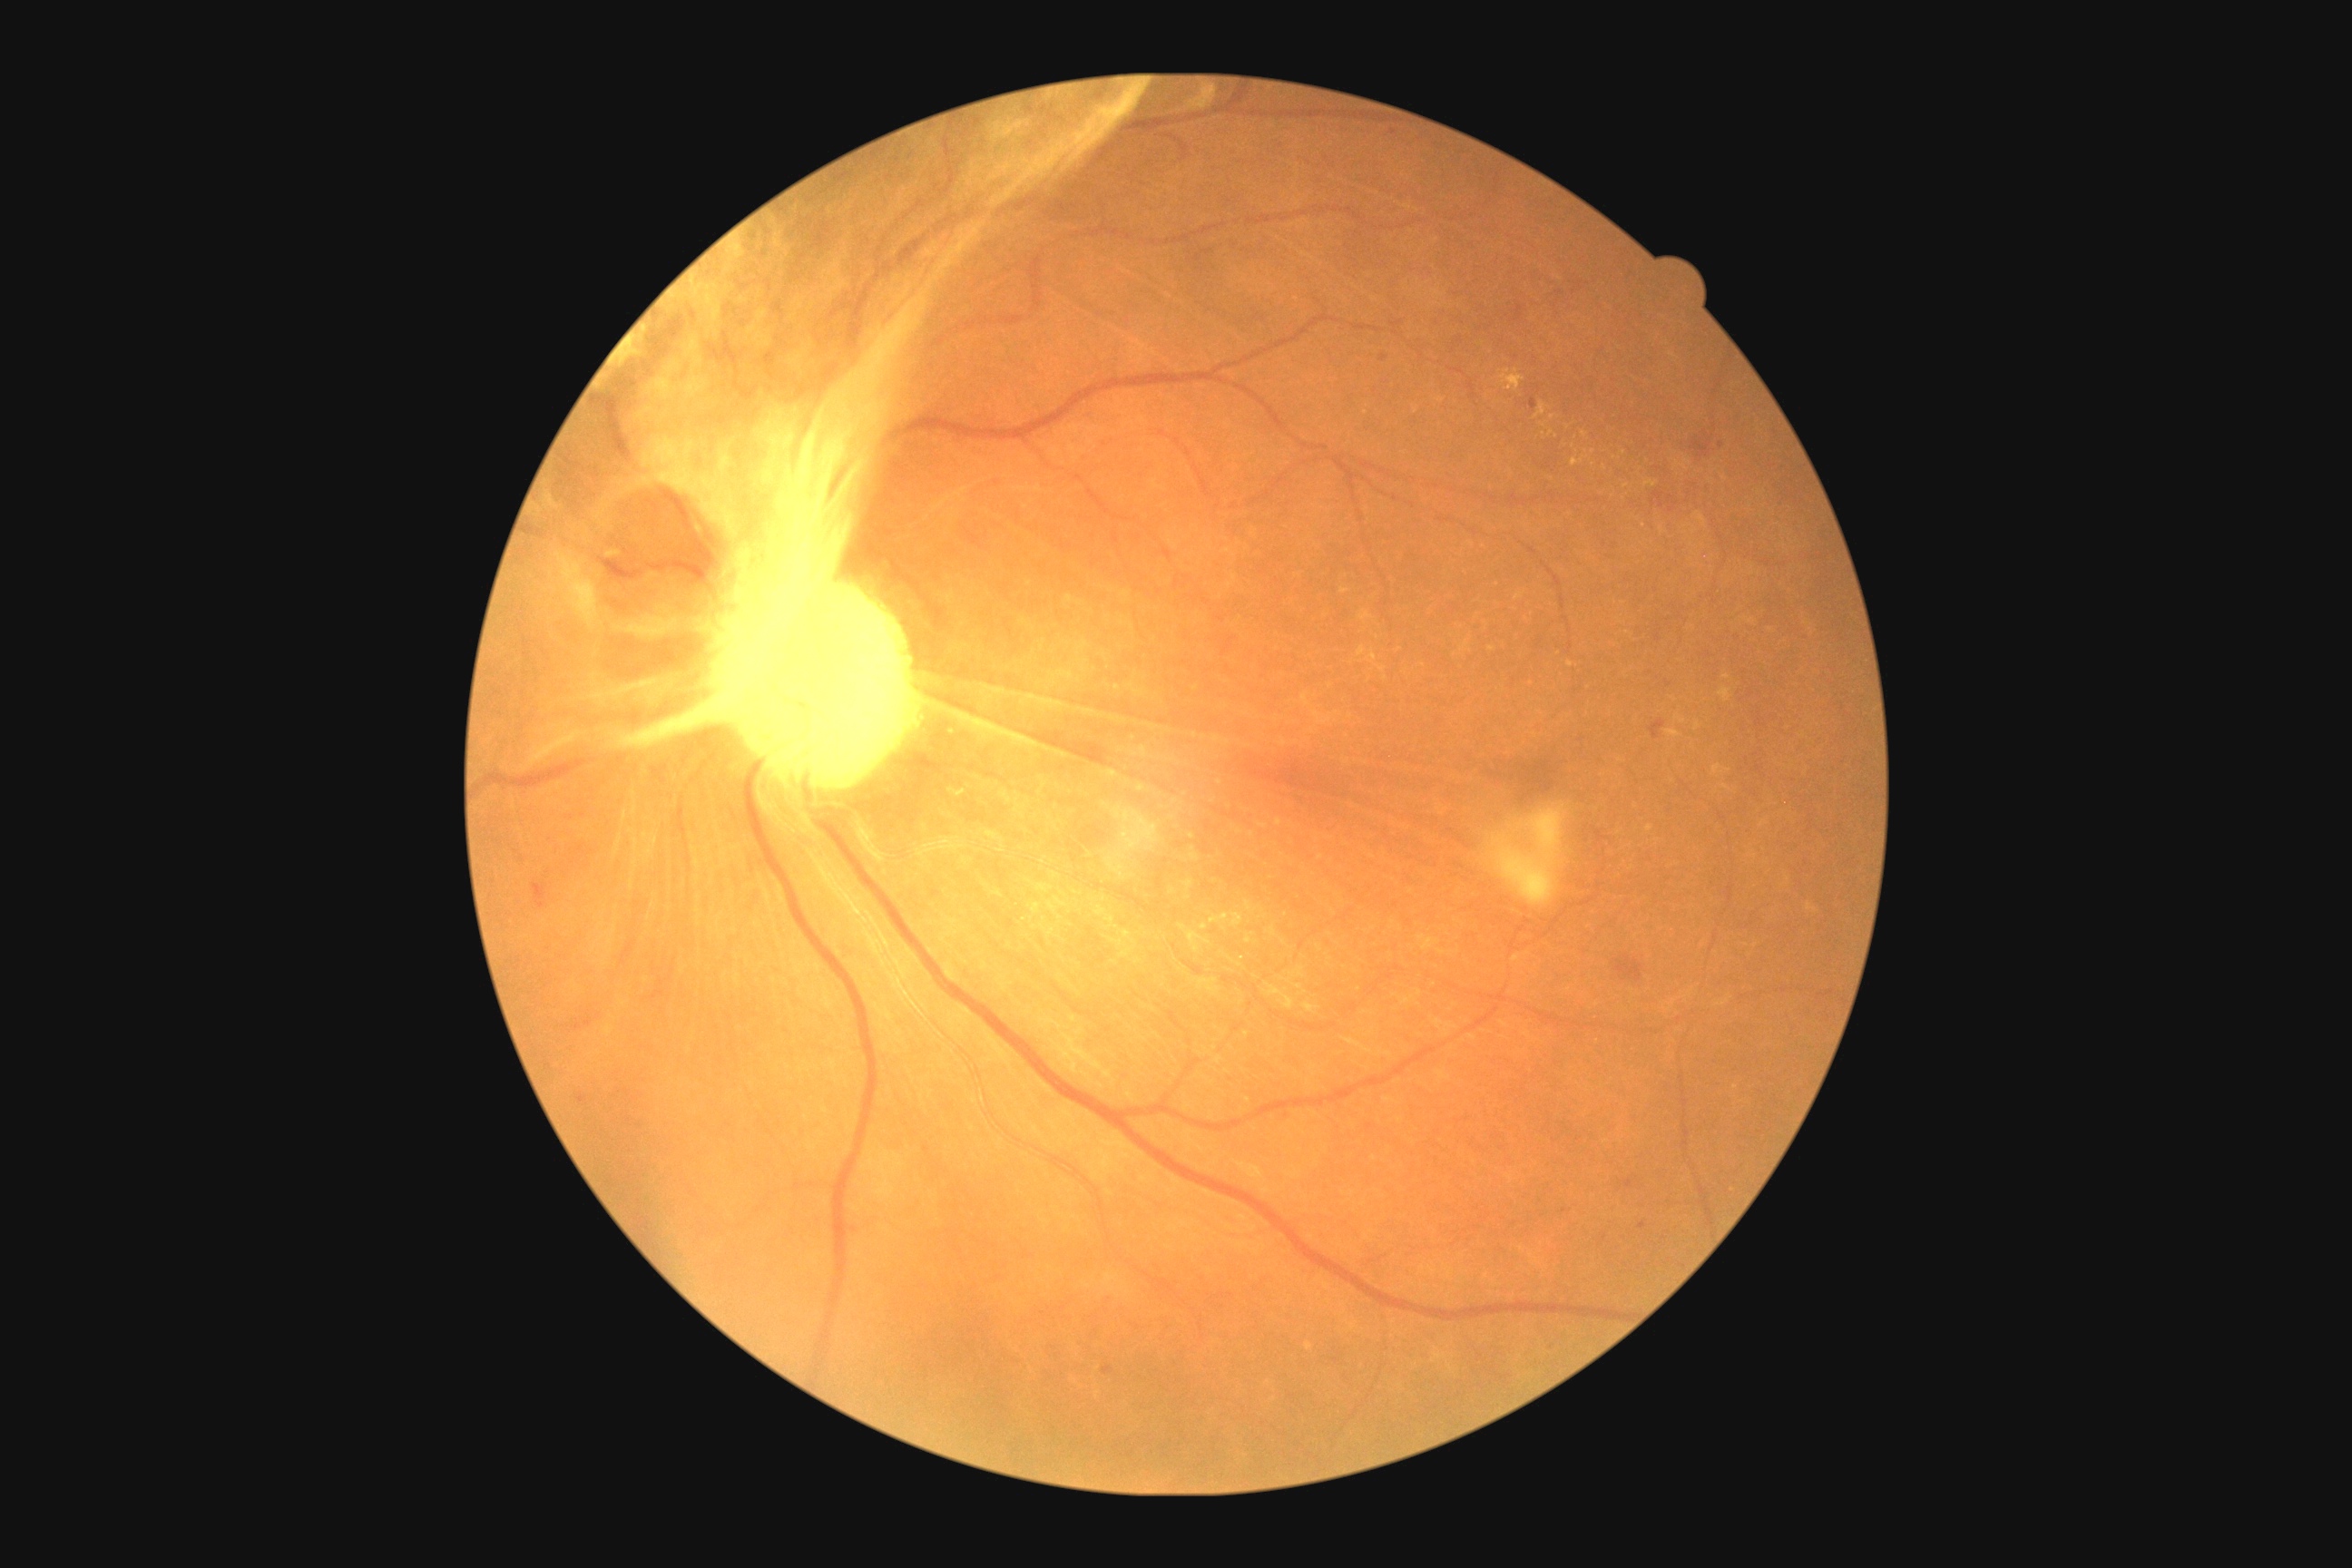 dr_grade: grade 4 (PDR)